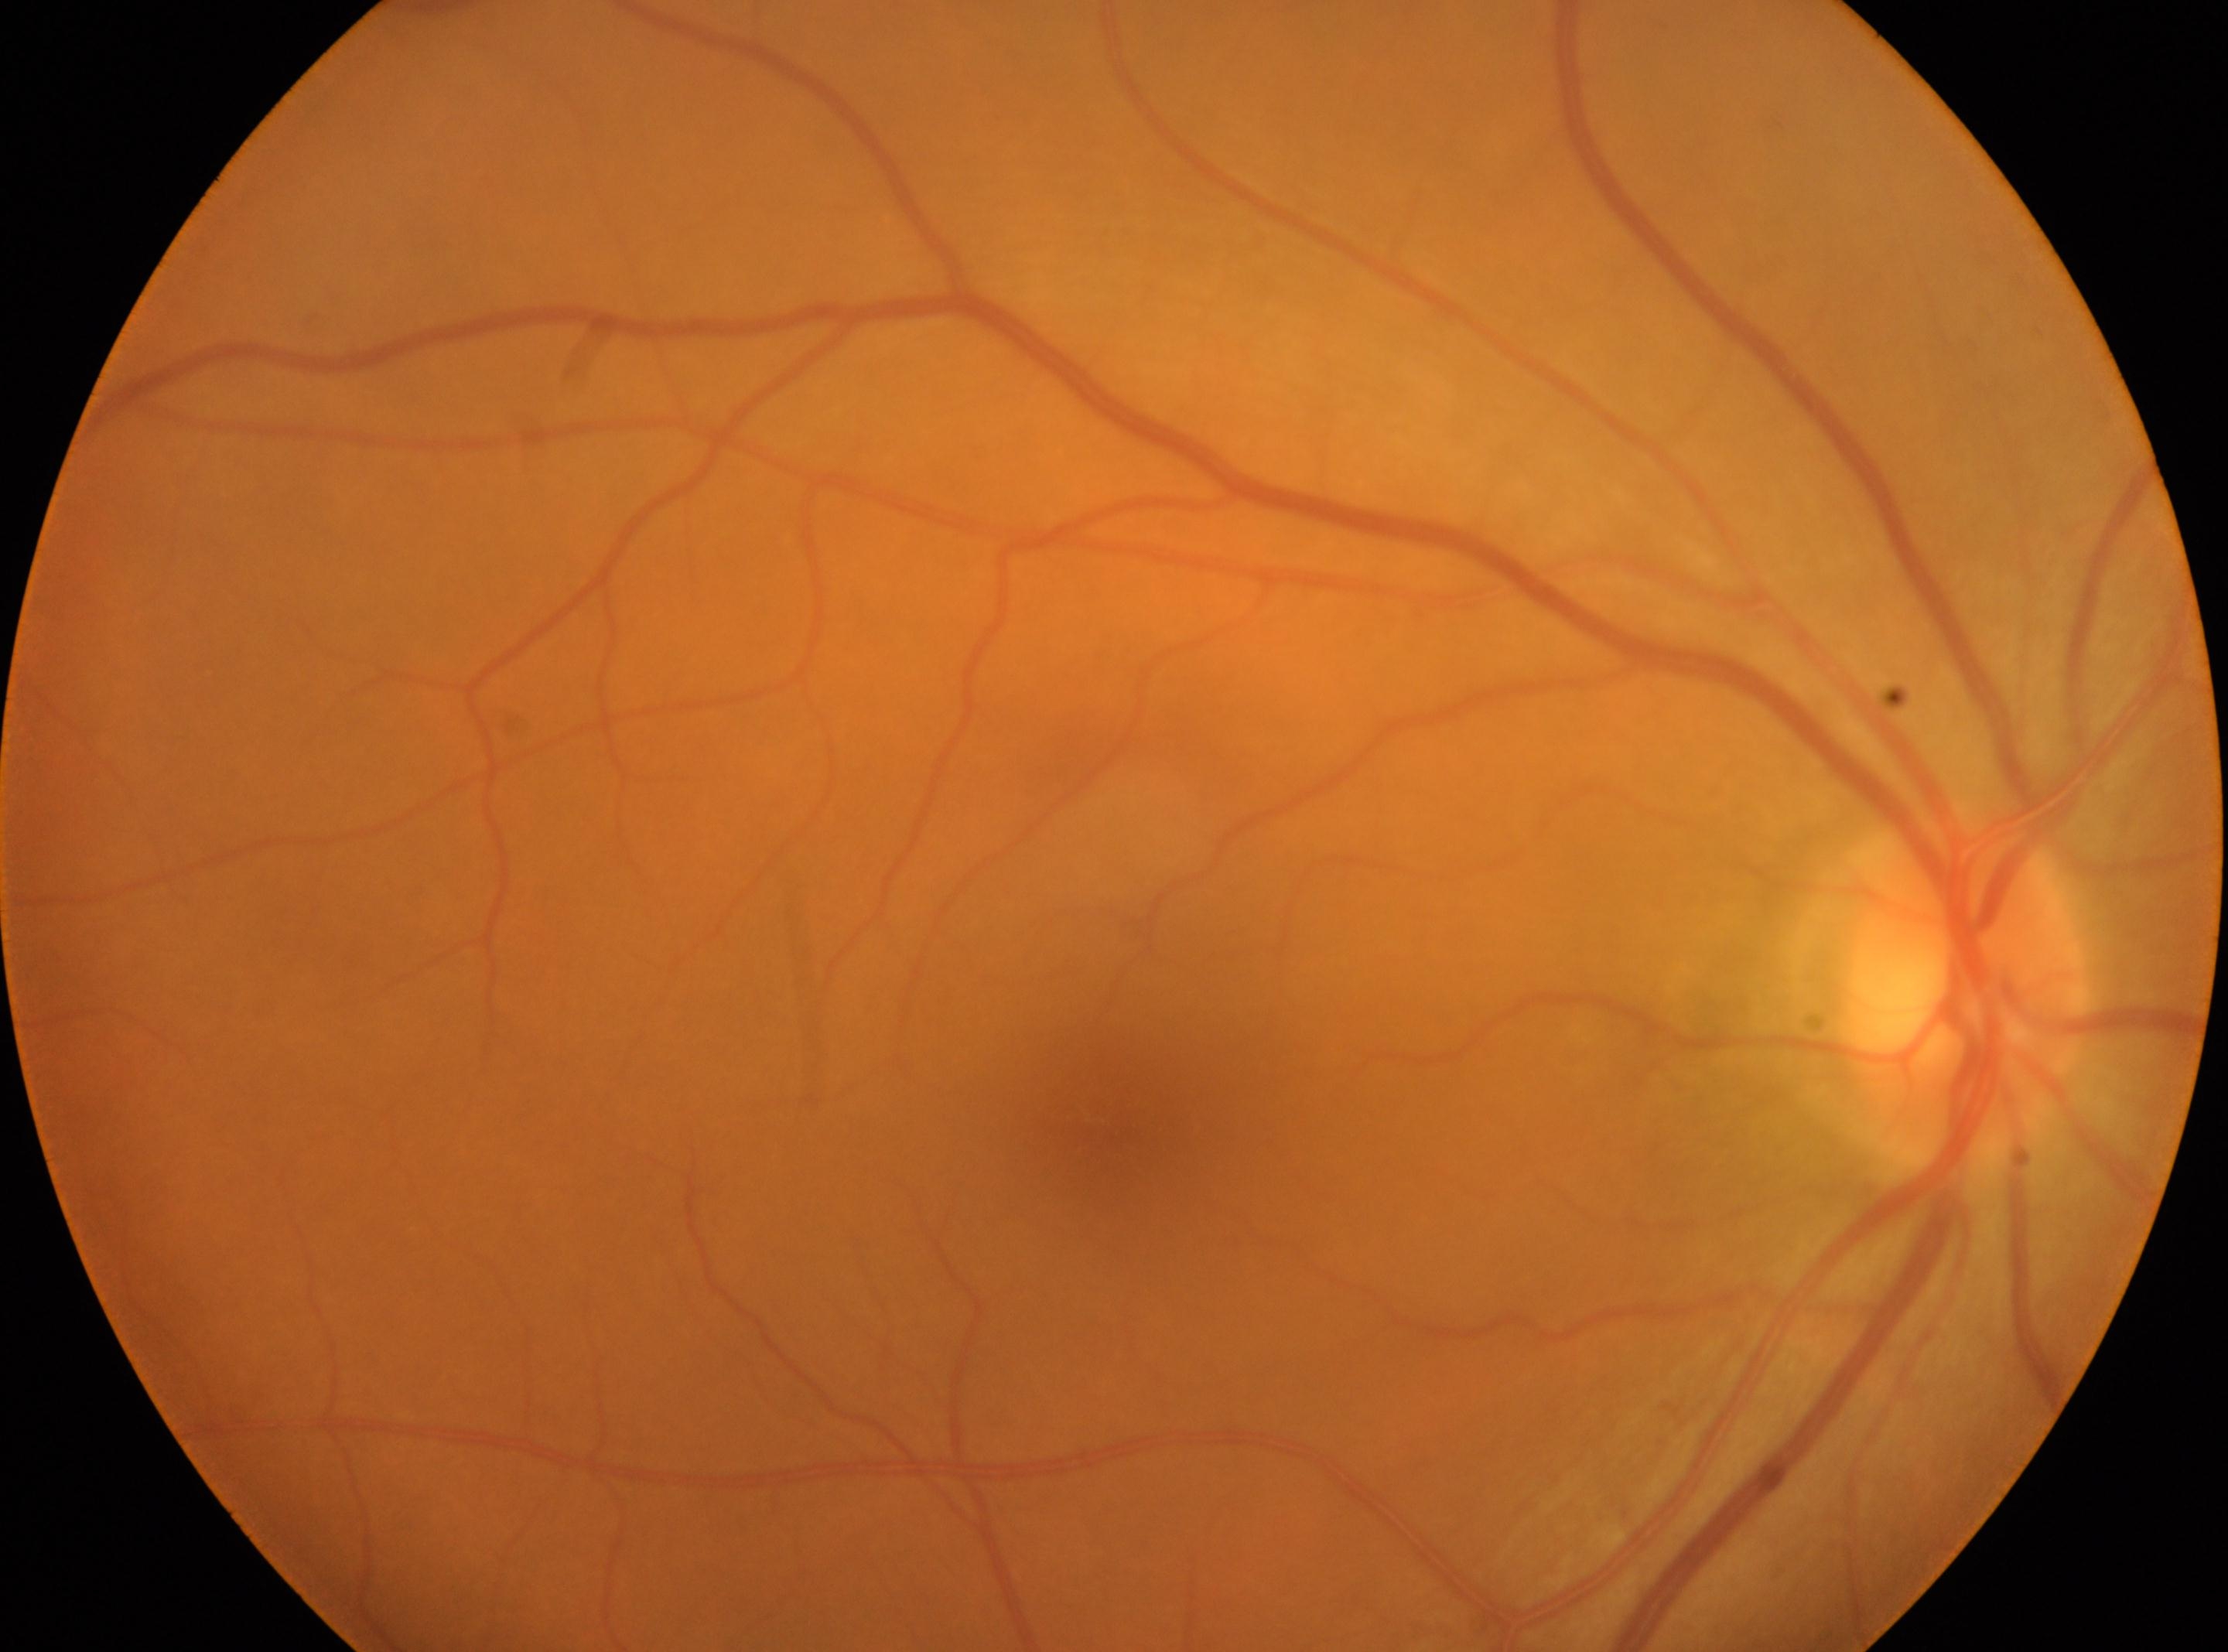 The optic nerve head is at 1967px, 987px.
DR stage: grade 0 (no apparent retinopathy).
The image shows the oculus dexter.
Fovea: 1100px, 1132px.